2346x1568px
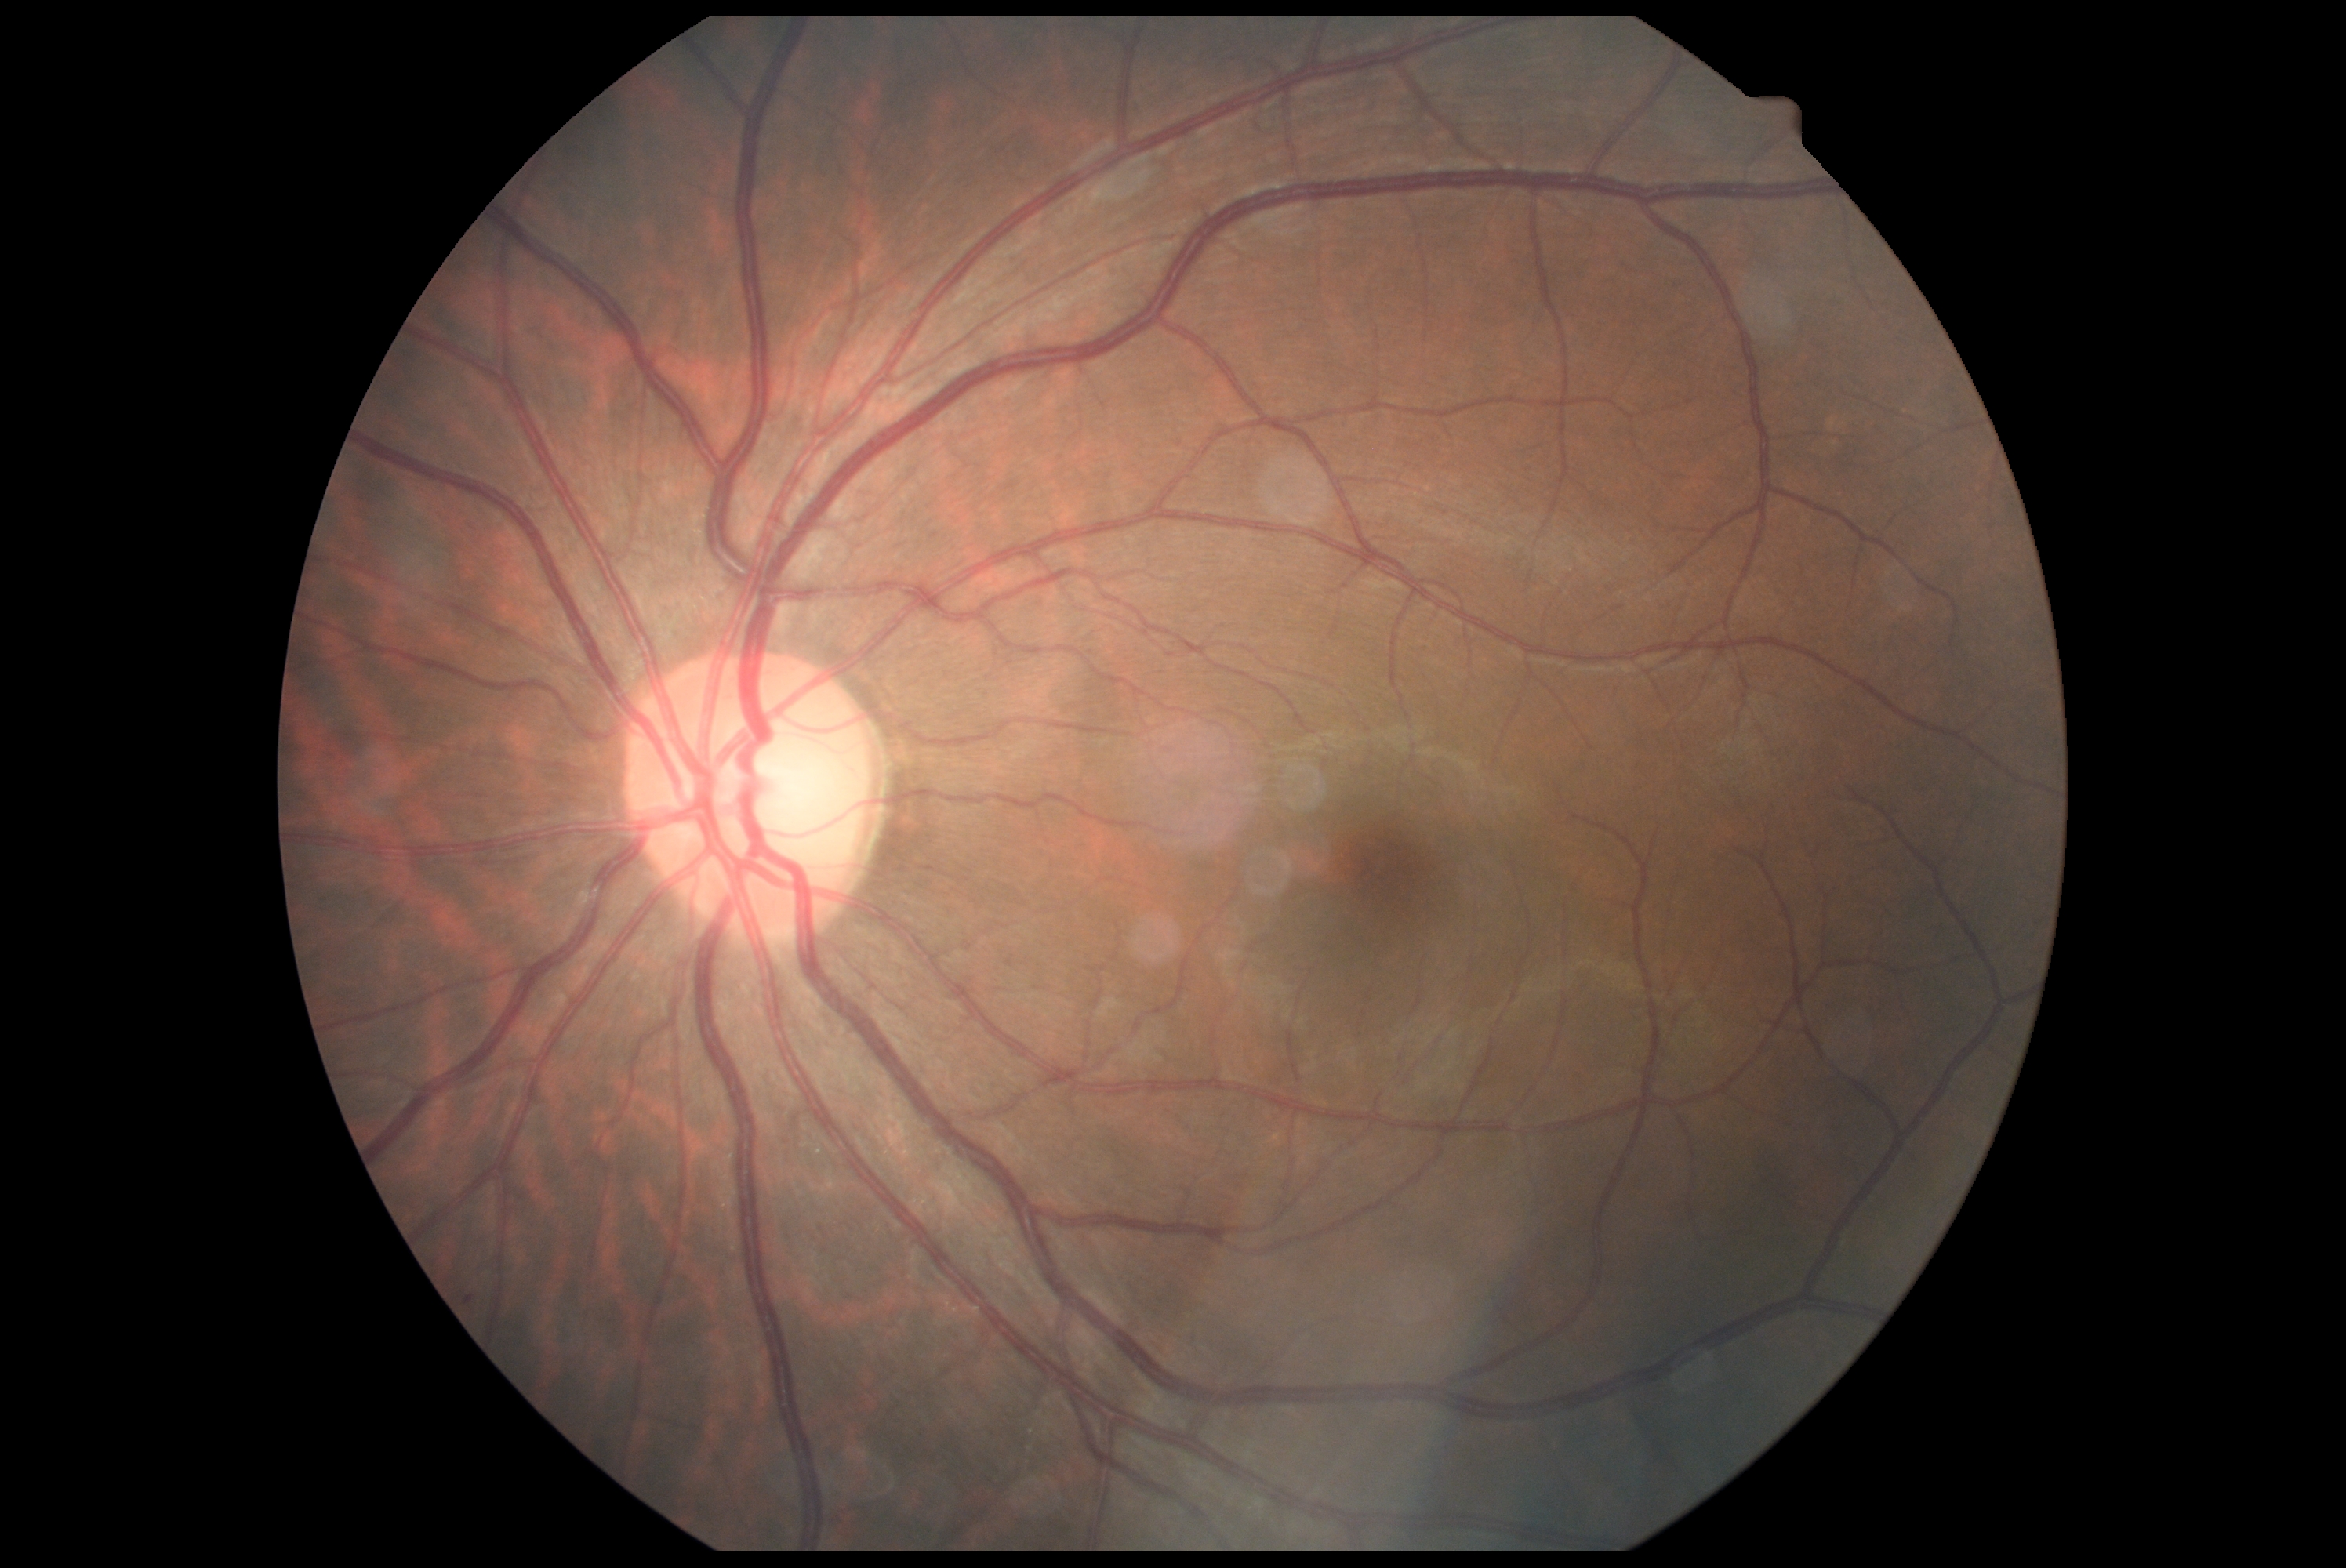

DR severity: grade 0 (no apparent retinopathy).